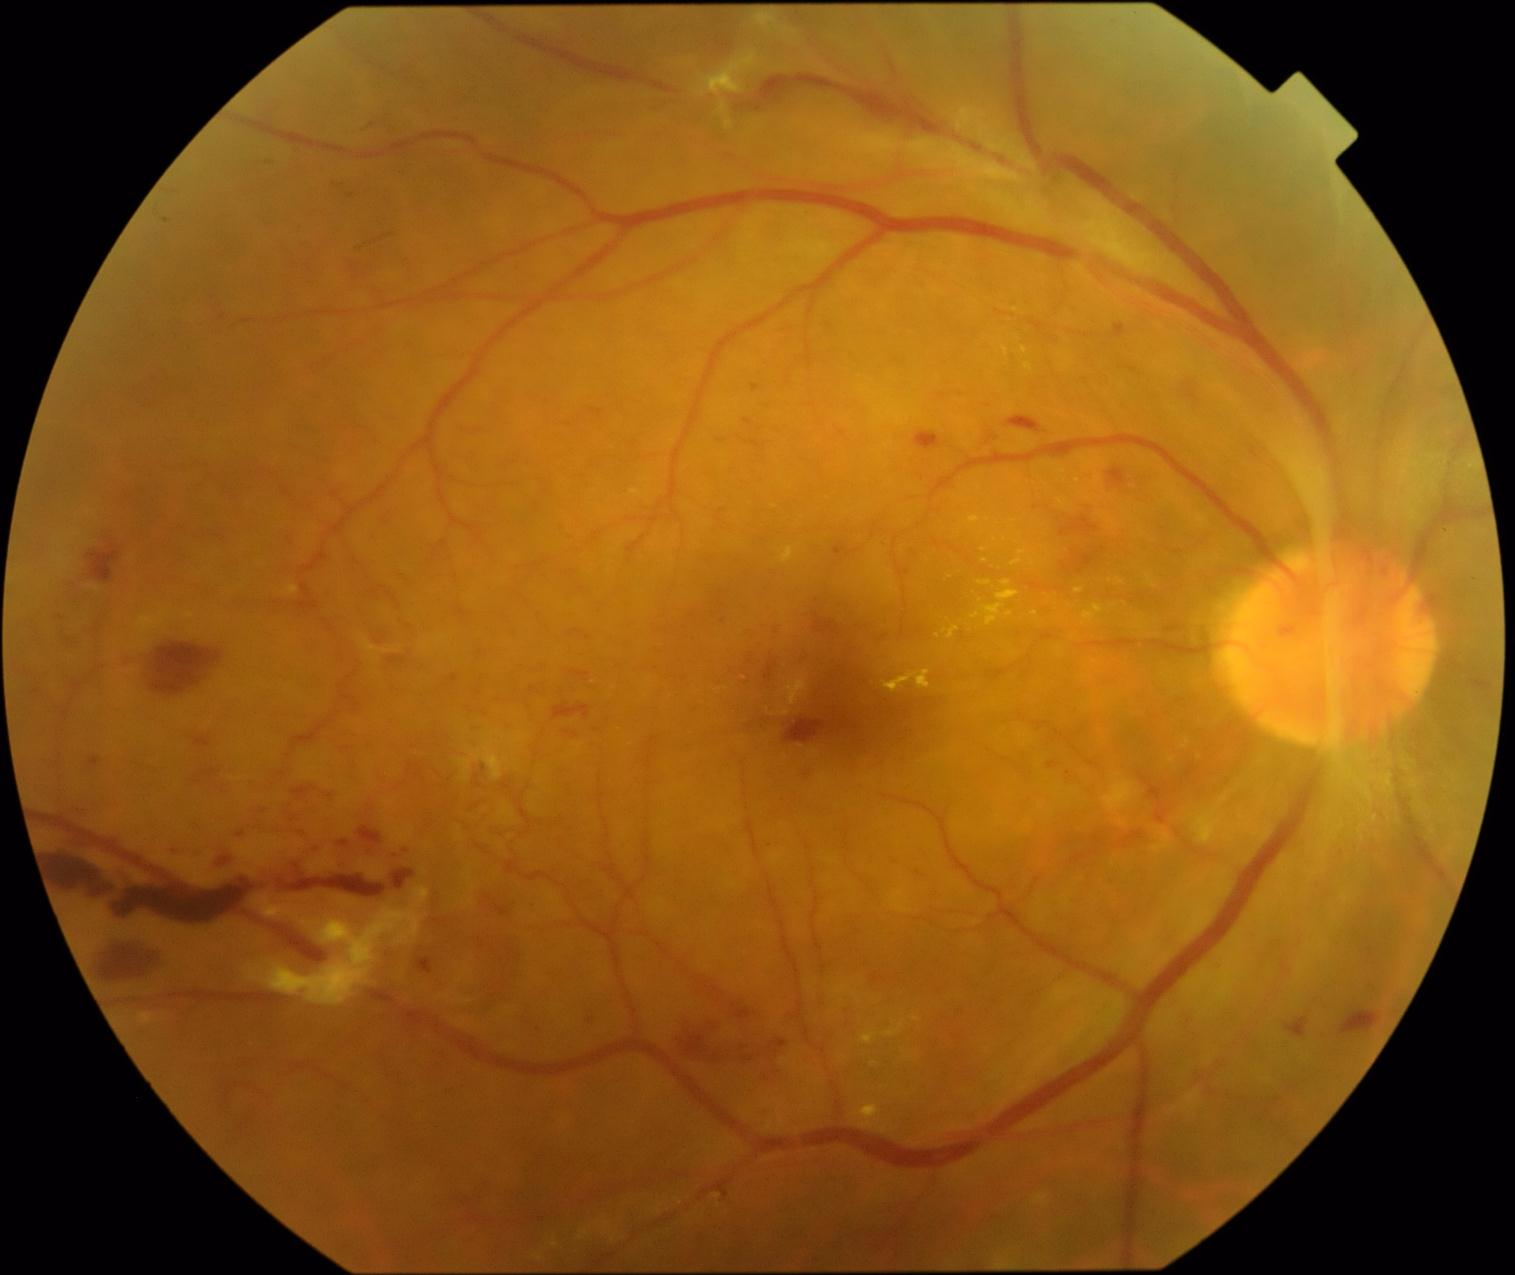 <lesions partial="true">
  <dr_grade>4</dr_grade>
  <he partial="true">[187,766,222,789]; [90,936,169,986]; [358,828,382,845]; [1187,390,1199,401]; [764,664,774,682]; [449,676,458,684]; [417,960,433,976]; [278,778,339,820]; [1341,1013,1379,1036]; [391,870,416,892]; [671,957,793,1088]; [1074,856,1088,864]; [1285,1019,1309,1039]; [88,754,106,773]; [401,847,420,858]; [1077,556,1094,575]; [836,1005,859,1030]</he>
  <ex partial="true">[1083,604,1106,626]; [1025,363,1034,372]; [943,628,959,639]; [968,516,981,526]; [971,581,1021,628]; [1002,347,1009,357]; [1075,590,1084,594]; [1011,560,1022,567]</ex>
  <ex_small_approx>pt(1025, 350); pt(1113, 607); pt(1034, 564); pt(984, 551); pt(1036, 614); pt(774, 507); pt(988, 521)</ex_small_approx>
  <ma />
  <se />
</lesions>